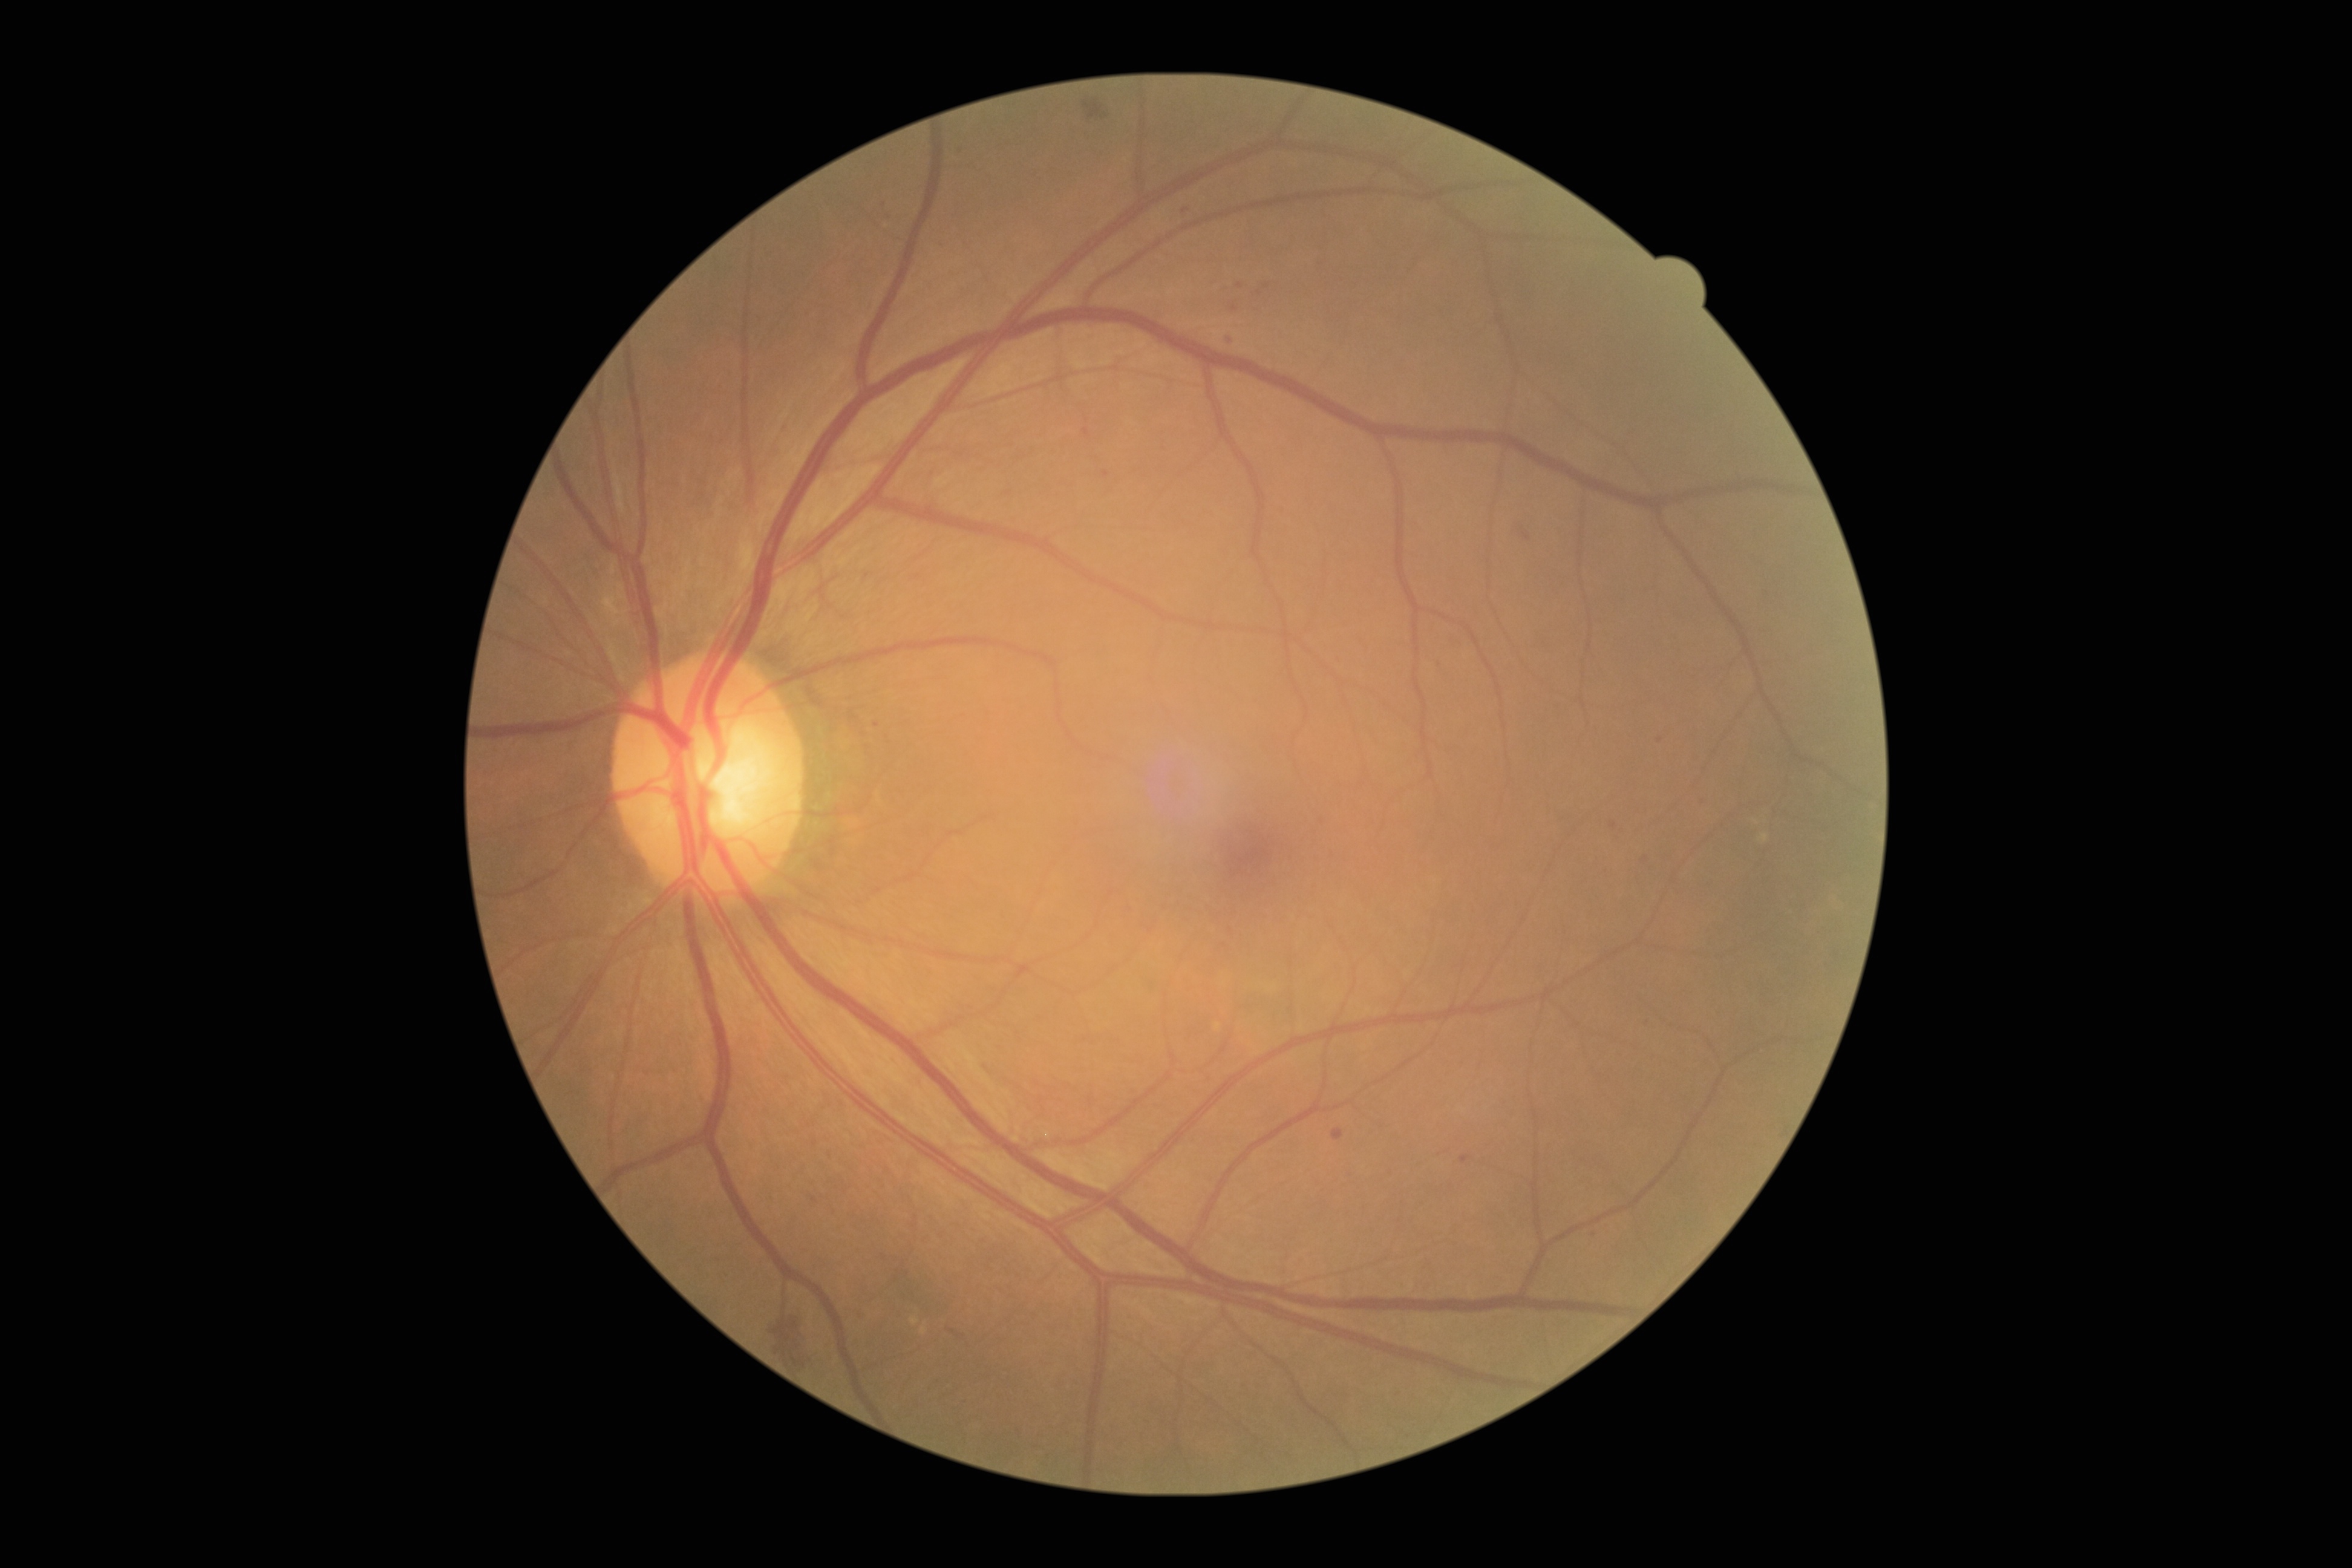 dr_grade: 2
dr_grade_name: moderate NPDR
lesions:
  ma:
    - x1=1230 y1=303 x2=1238 y2=313
    - x1=1331 y1=1128 x2=1345 y2=1140
    - x1=1698 y1=797 x2=1709 y2=805
    - x1=1642 y1=1016 x2=1651 y2=1028
    - x1=1103 y1=471 x2=1109 y2=479
    - x1=1226 y1=335 x2=1235 y2=345
    - x1=1460 y1=1155 x2=1469 y2=1163
    - x1=958 y1=145 x2=964 y2=153
    - x1=871 y1=719 x2=880 y2=729
    - x1=1082 y1=428 x2=1089 y2=436
    - x1=1642 y1=851 x2=1651 y2=862
  ma_small_approx:
    - 1614, 825
    - 1594, 1234
    - 1186, 210
    - 1240, 286
    - 1660, 740
    - 1260, 293
    - 1267, 287
  se: []
  he:
    - x1=948 y1=1324 x2=977 y2=1351
    - x1=771 y1=1316 x2=811 y2=1373
    - x1=881 y1=200 x2=895 y2=224
    - x1=1083 y1=99 x2=1109 y2=120
    - x1=1512 y1=518 x2=1534 y2=544
  ex: []